NIDEK AFC-230.
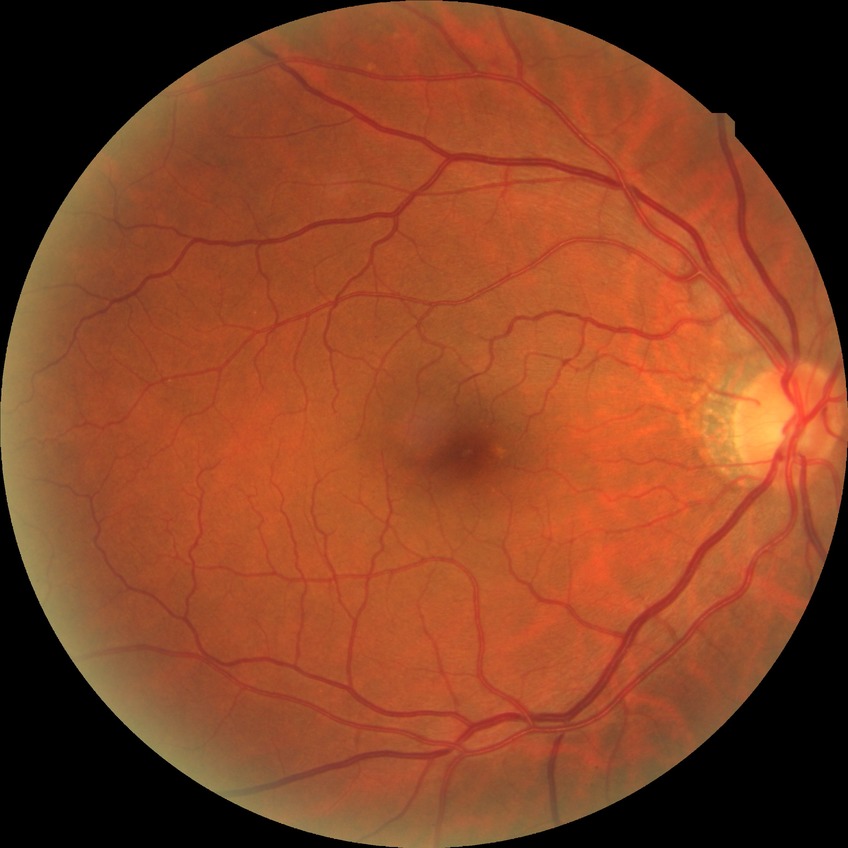

No diabetic retinal disease findings. Davis DR grade: NDR.